Color fundus photograph; 45° field of view
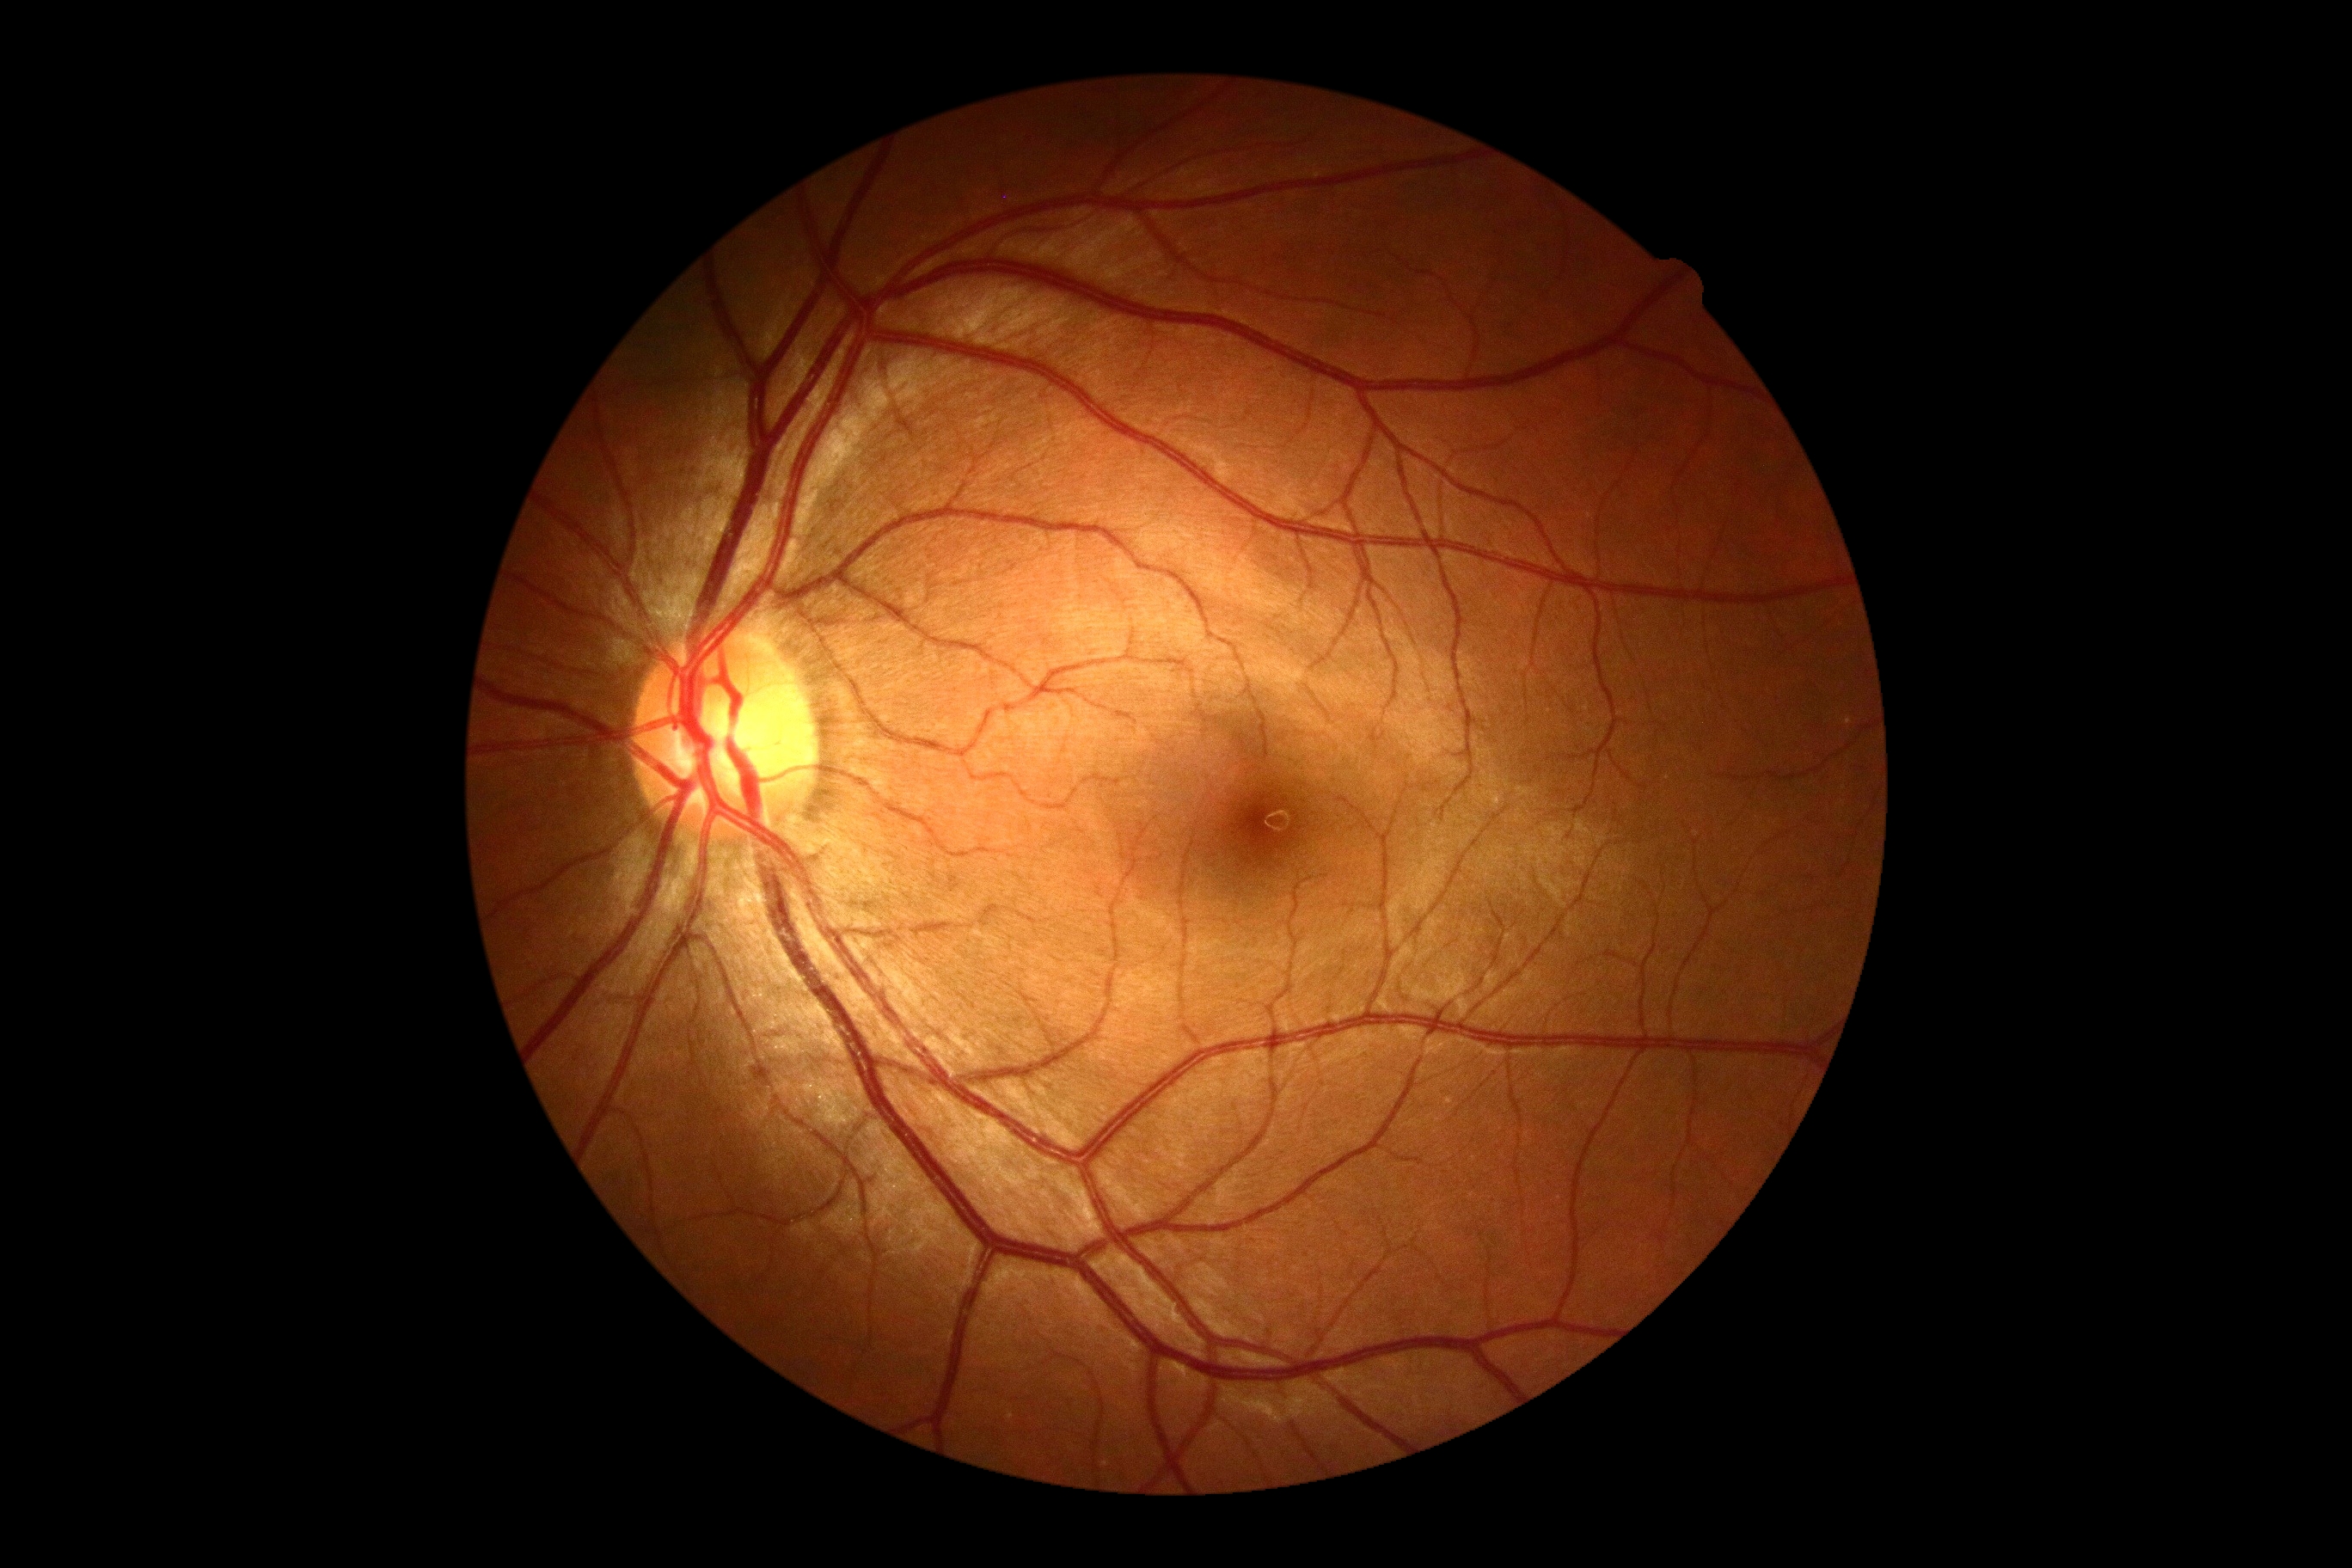
{"dr_grade": "no apparent diabetic retinopathy (0)"}